45° field of view:
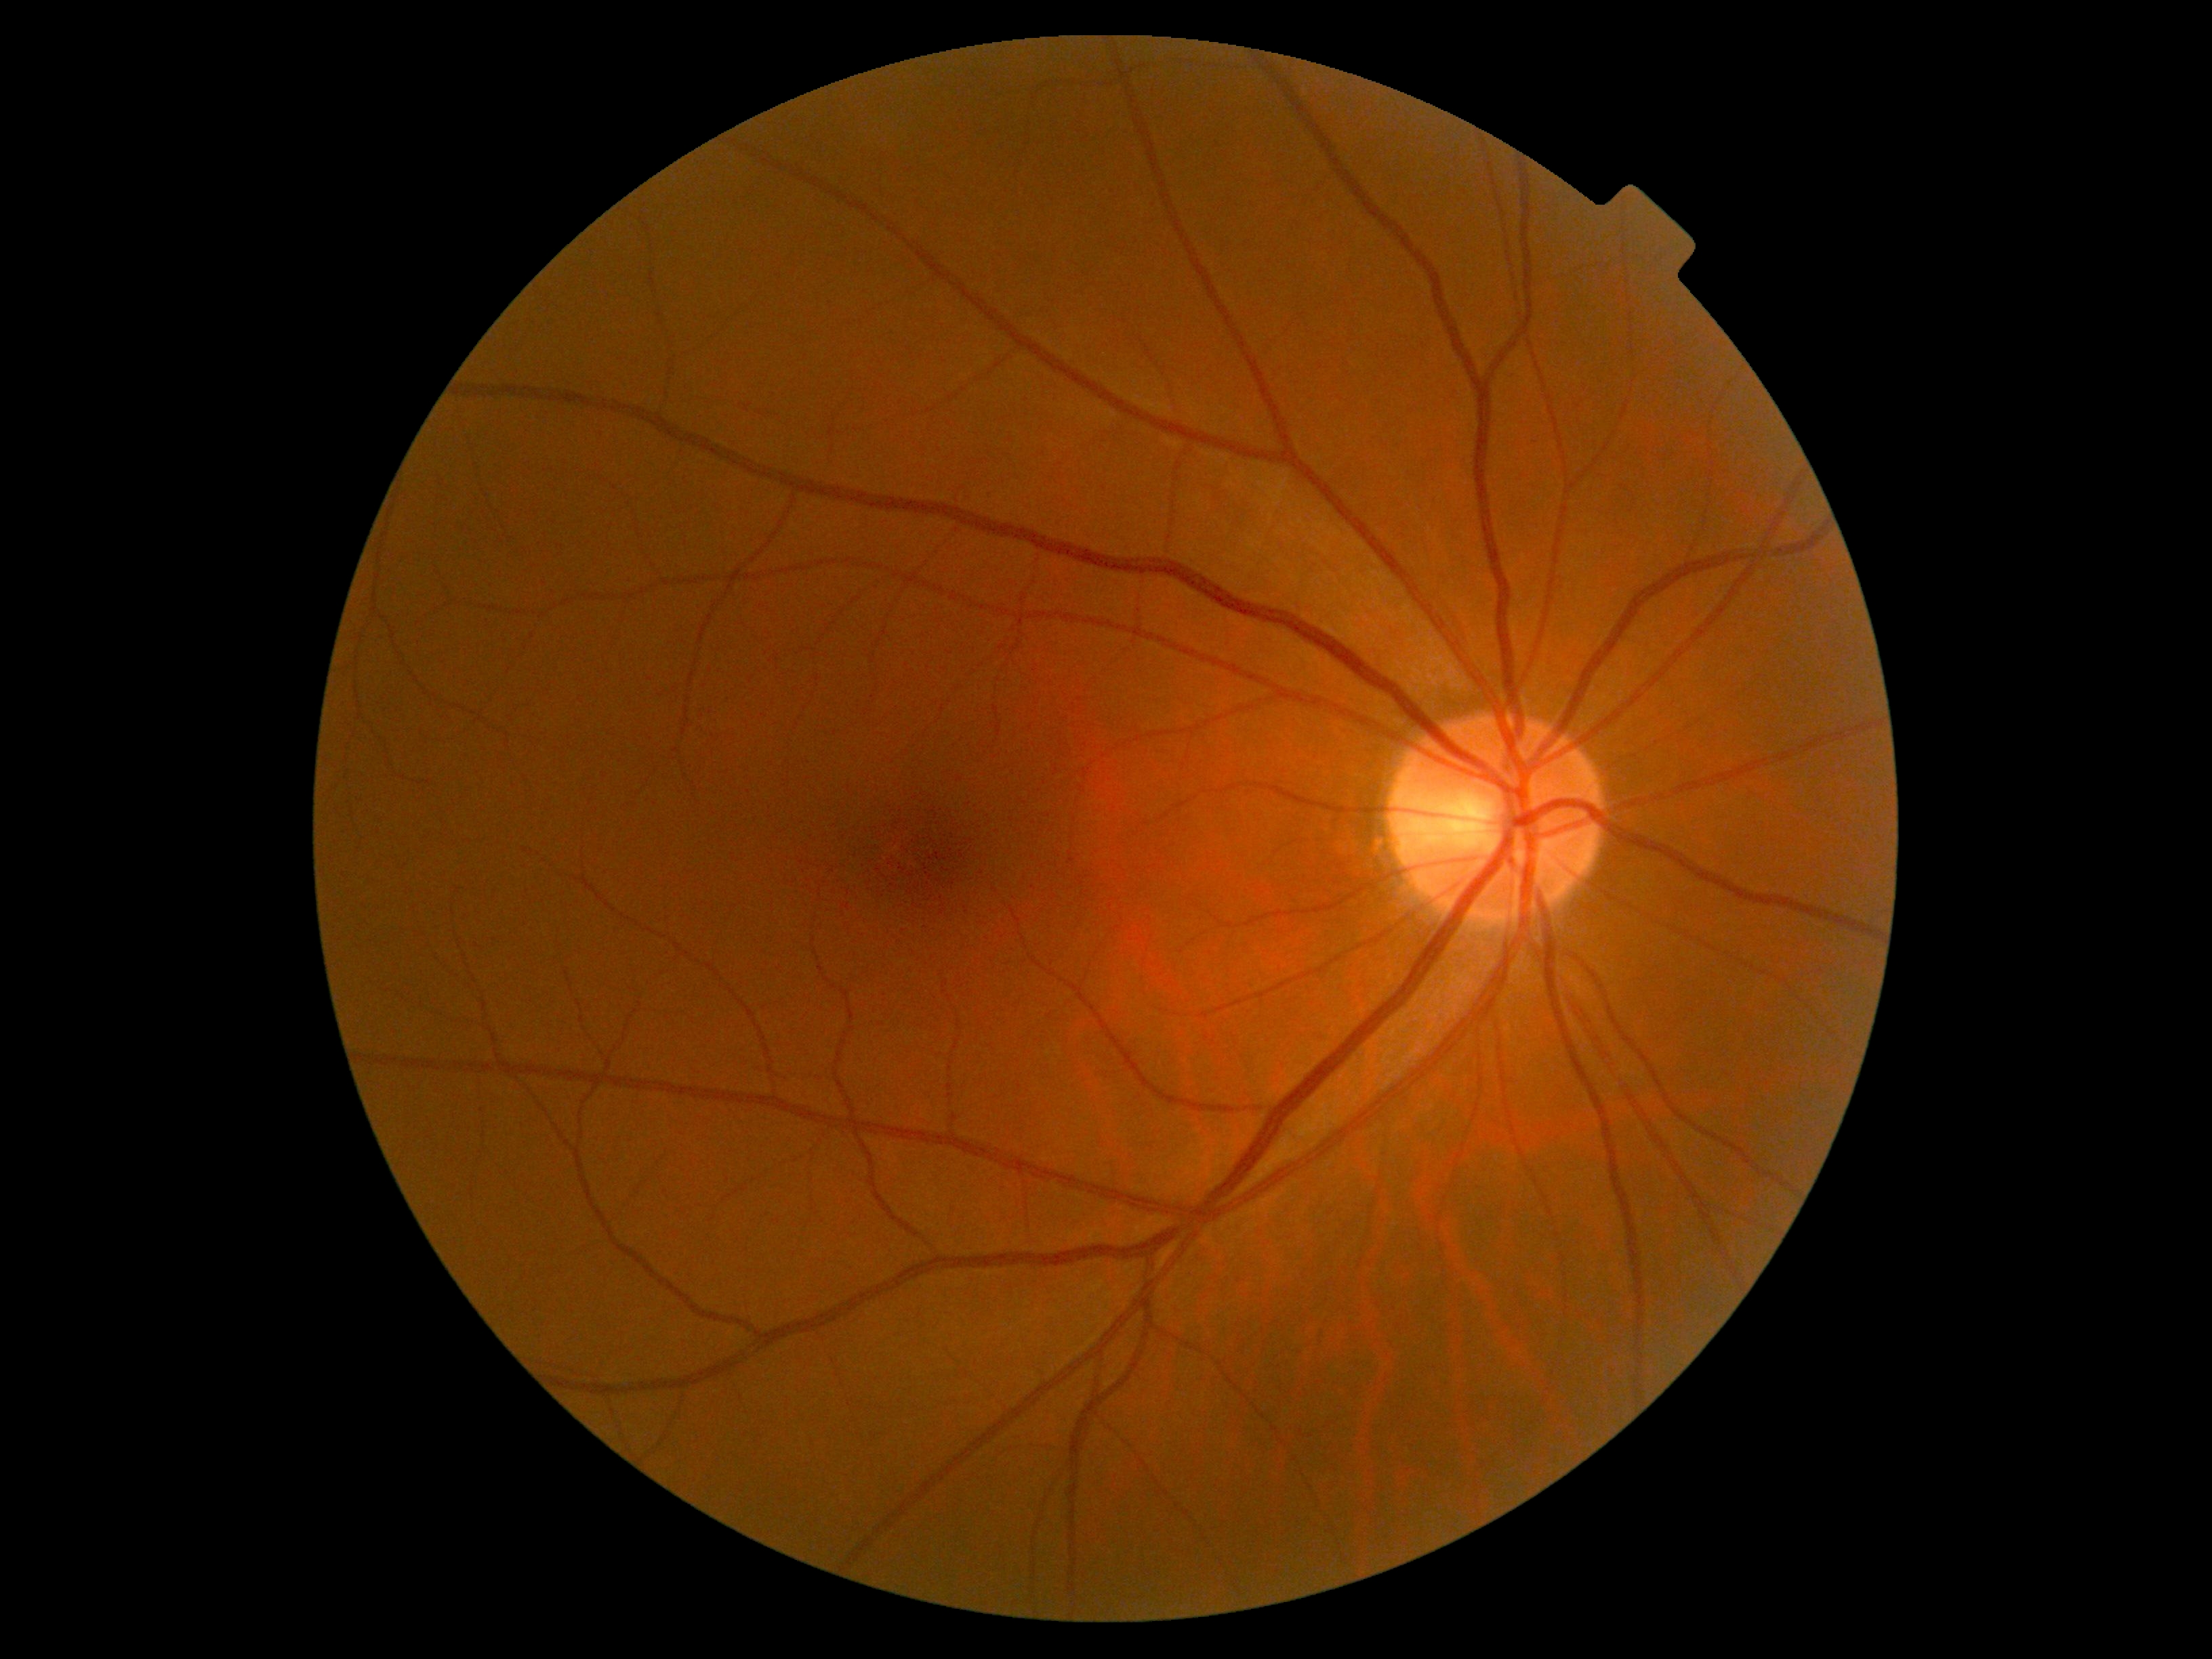

Diabetic retinopathy grade is 0 — no visible signs of diabetic retinopathy.